Phoenix ICON wide-field infant fundus image. 1240x1240:
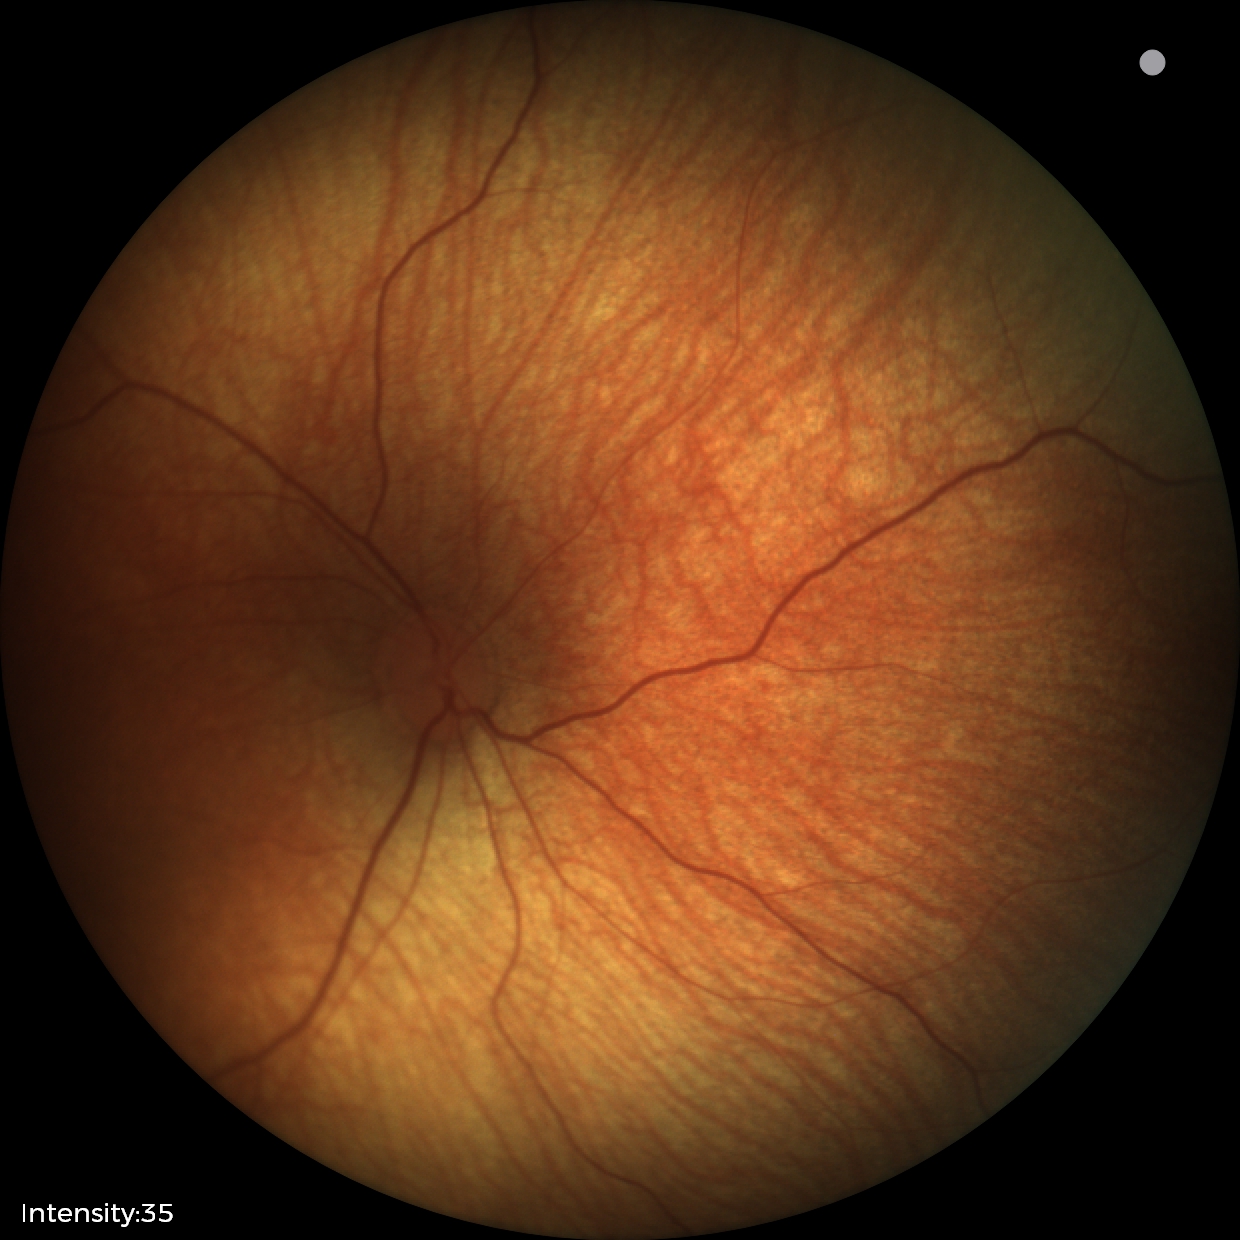 Physiological retinal appearance for postconceptual age.